848 x 848 pixels · camera: NIDEK AFC-230
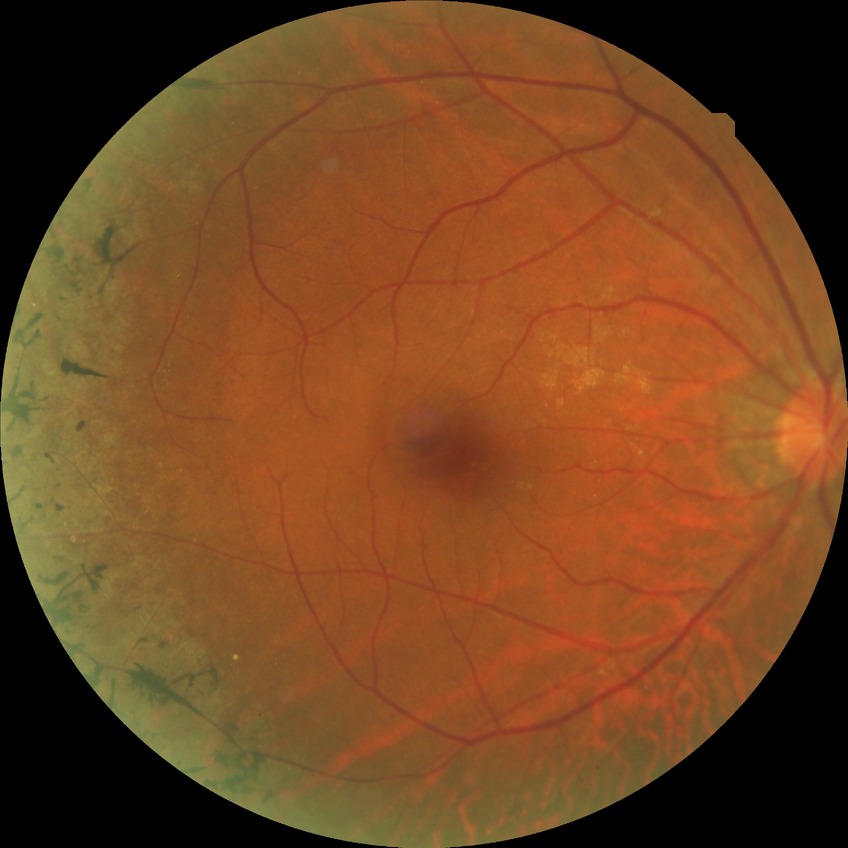
Diabetic retinopathy (DR) is no diabetic retinopathy (NDR).